Modified Davis grading
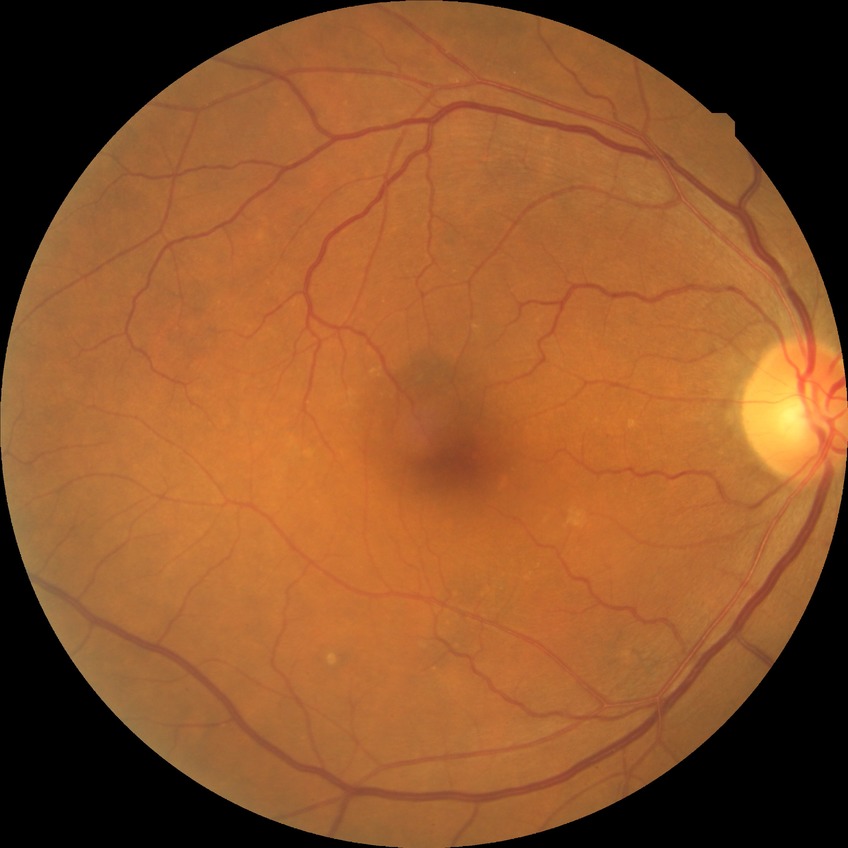
diabetic retinopathy (DR)@NDR (no diabetic retinopathy).